Remidio smartphone fundus camera · 1659x2212: 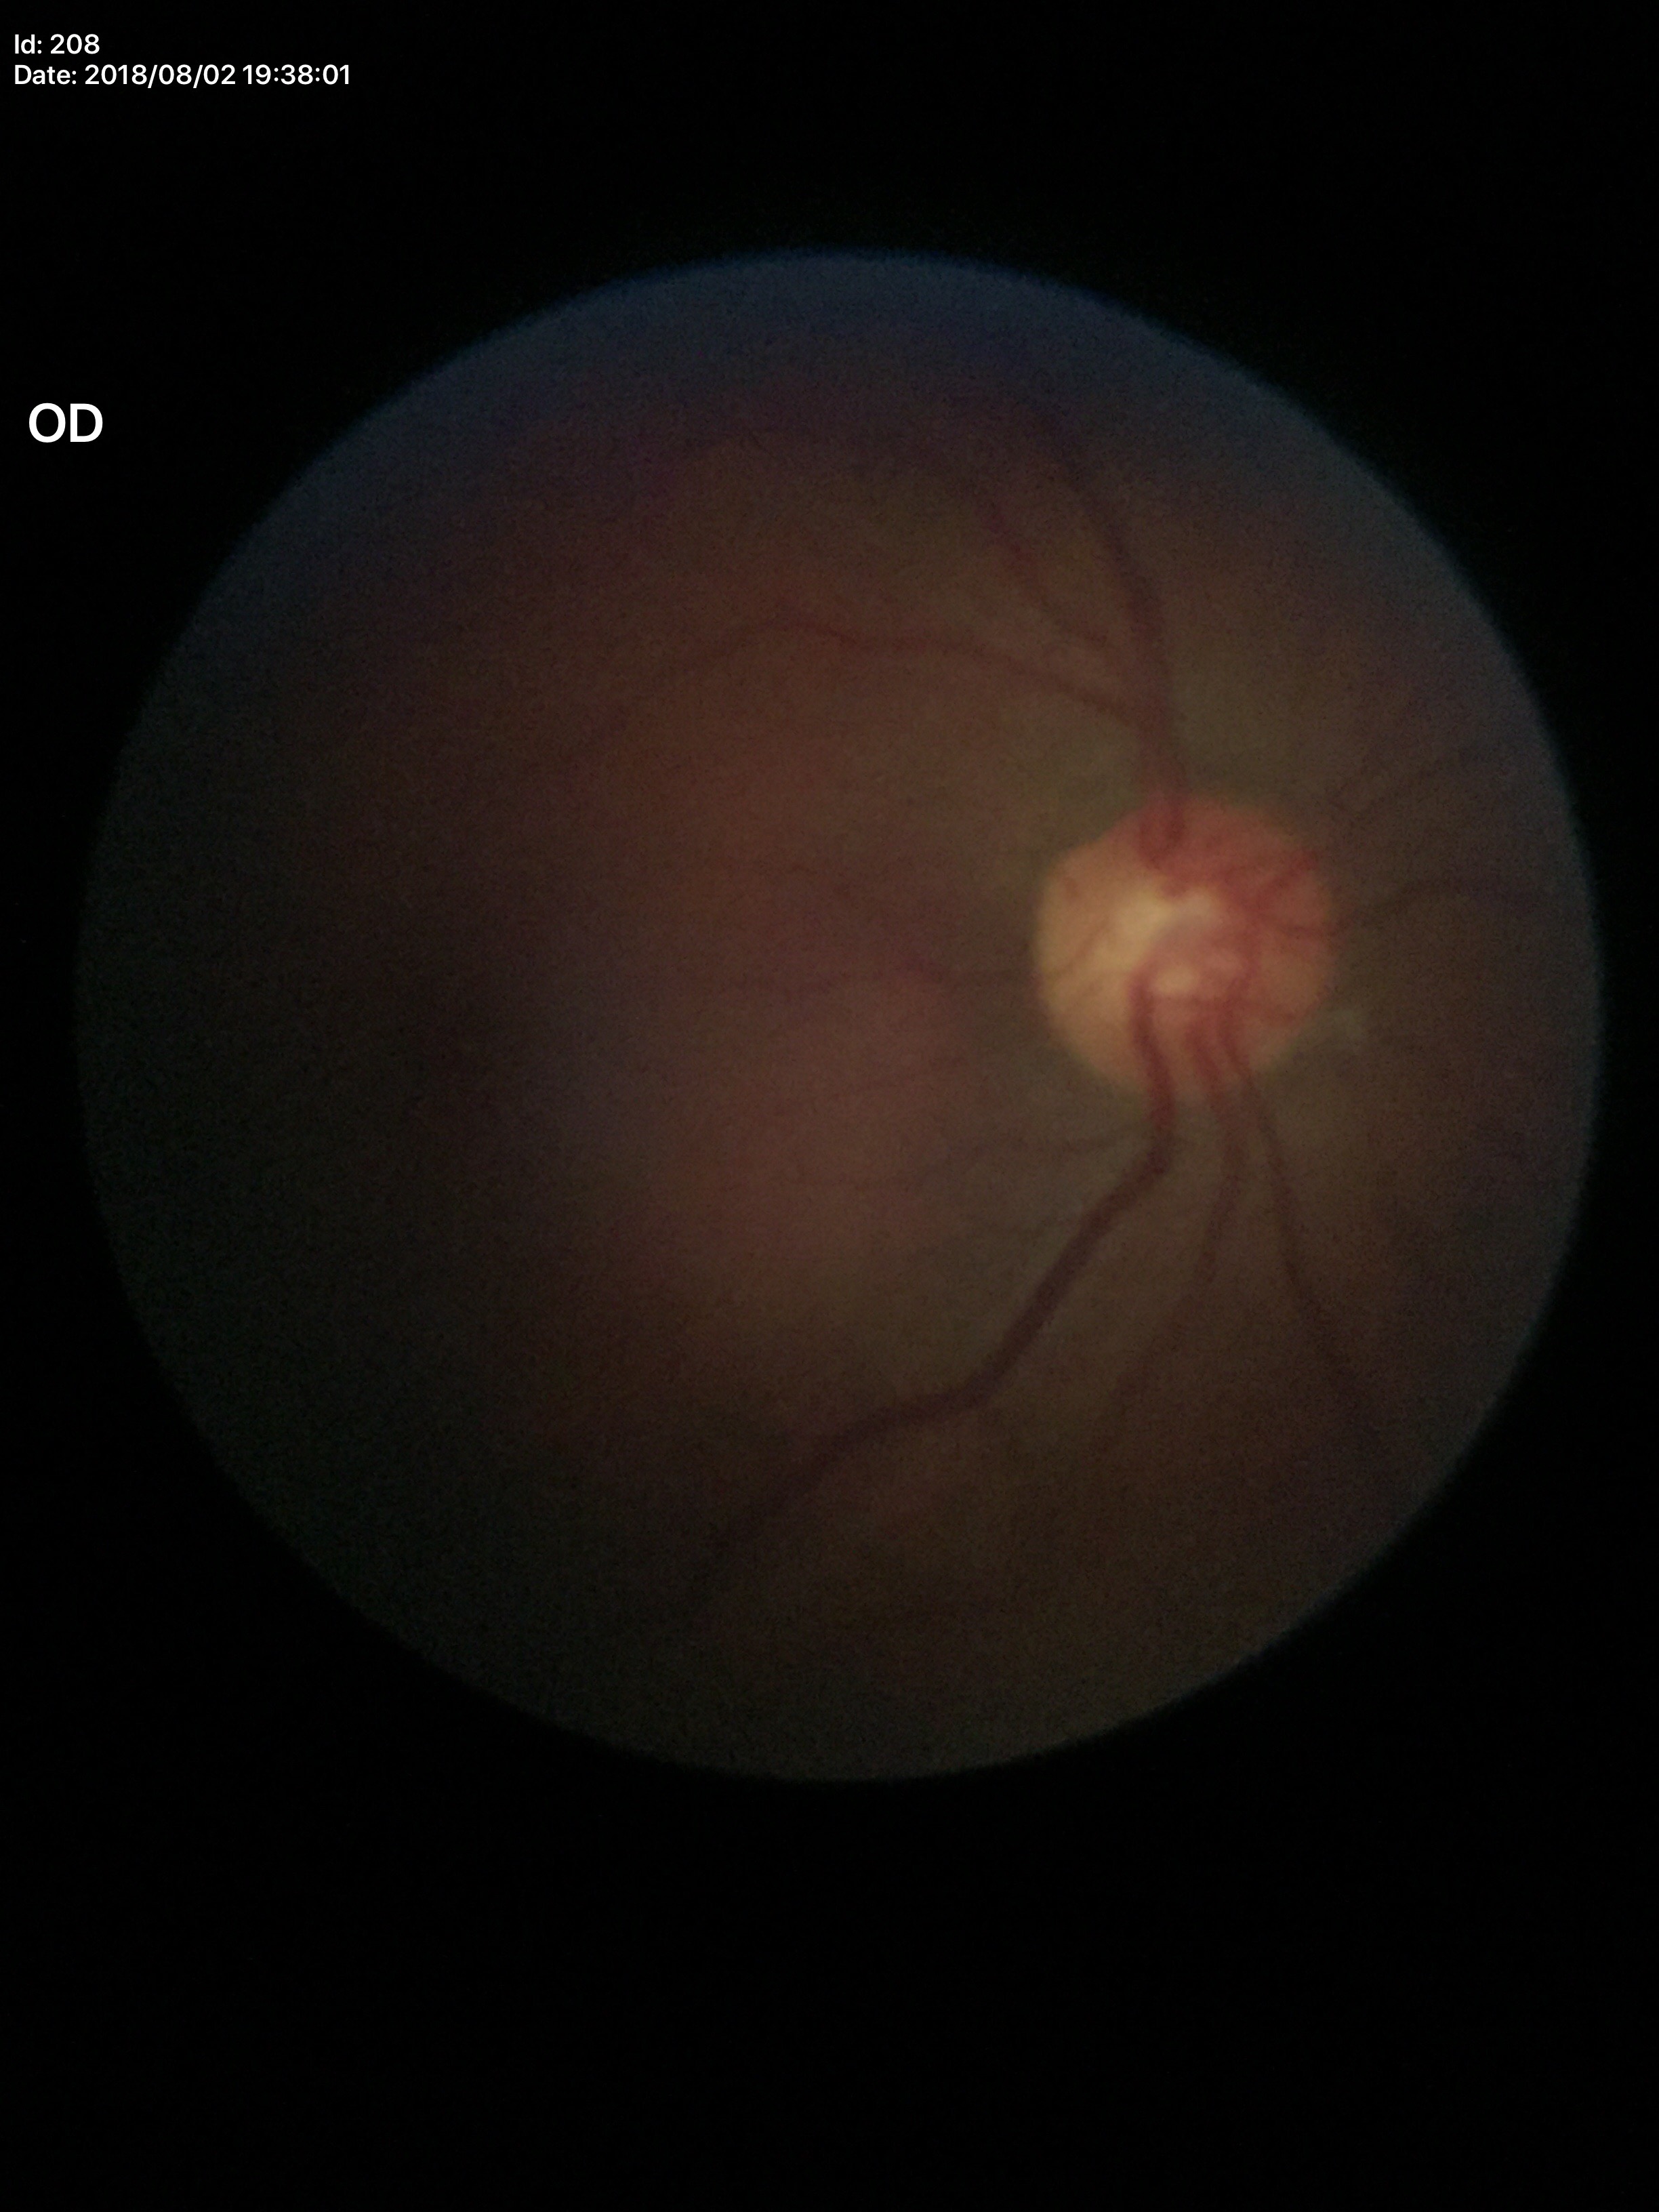 {
  "glaucoma_decision": "no suspicious findings",
  "vcdr": "0.51"
}